848 x 848 pixels; without pupil dilation:
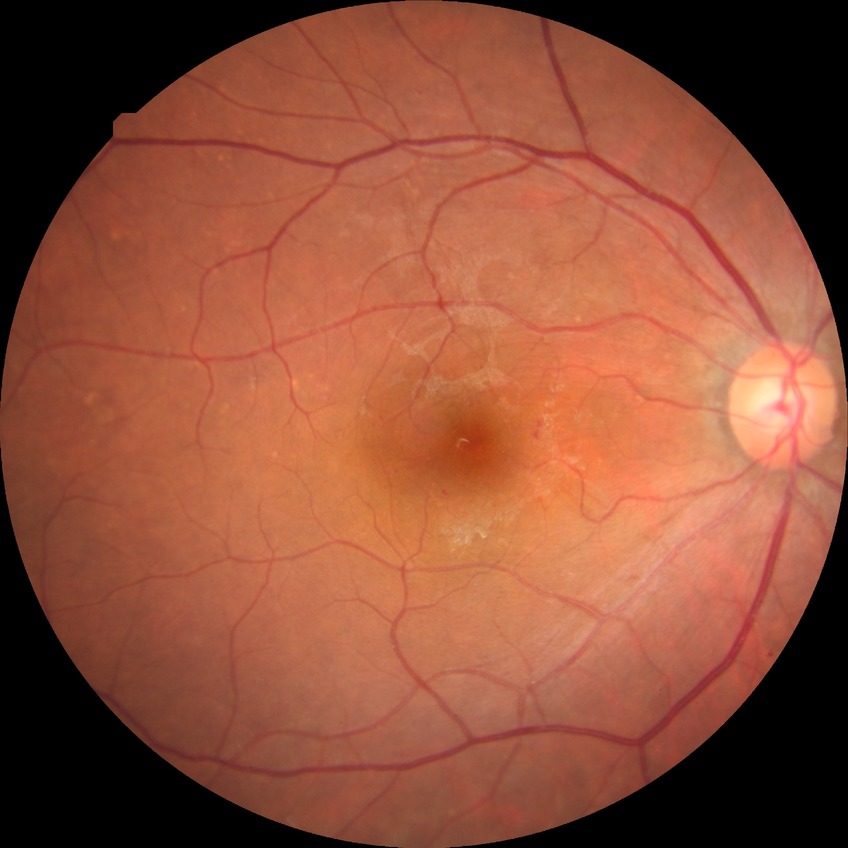 modified Davis grading = simple diabetic retinopathy